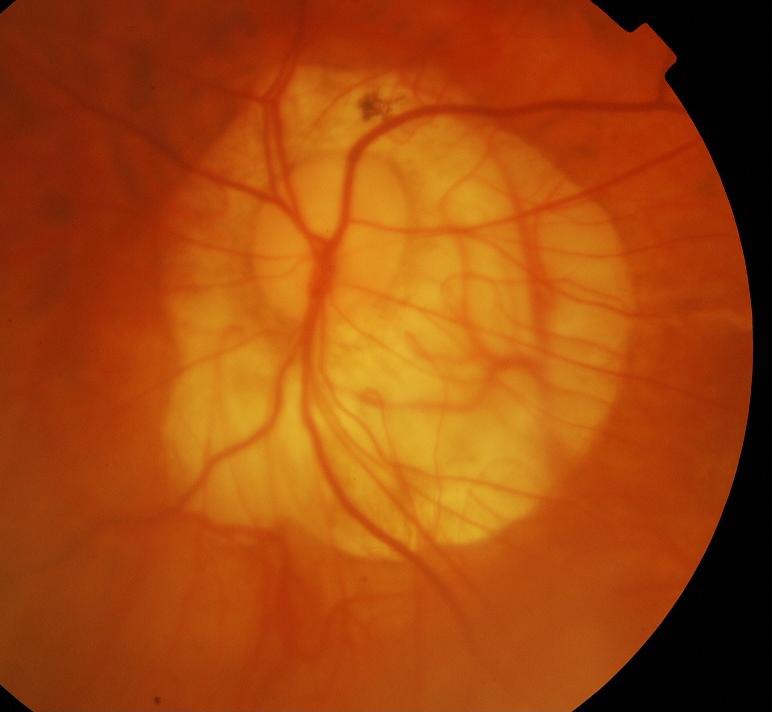

Q: What is the glaucoma diagnosis?
A: Yes — glaucomatous optic neuropathy.